Wide-field fundus image from infant ROP screening:
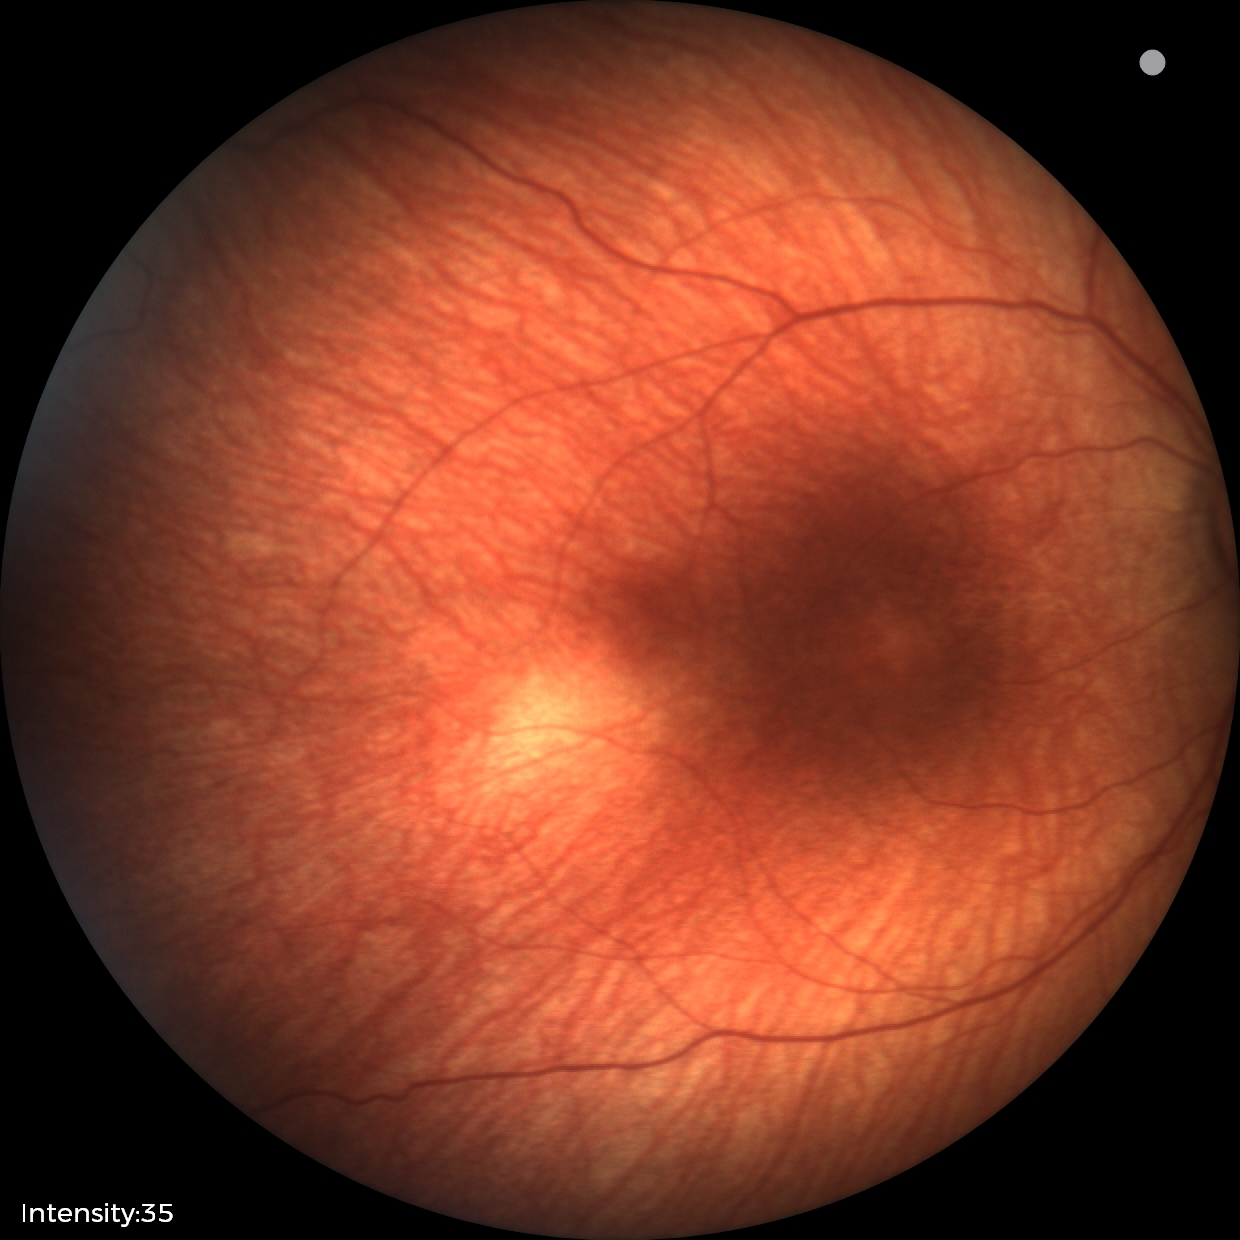

Screening diagnosis: status post retinopathy of prematurity.